Nonmydriatic:
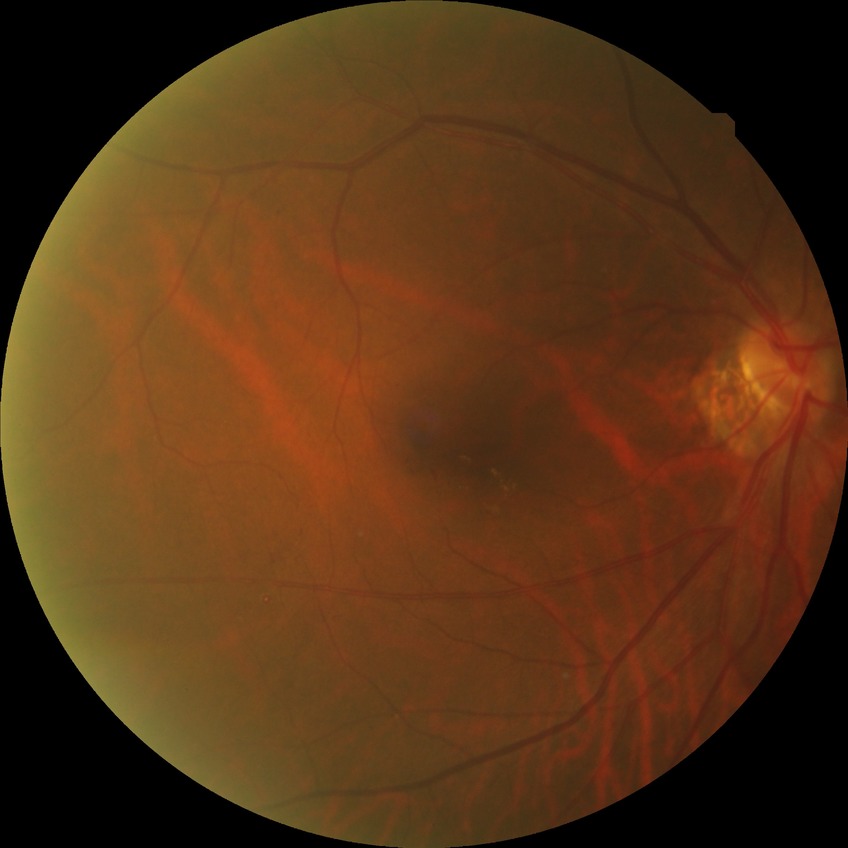
davis_grade: SDR (simple diabetic retinopathy)